FOV: 45 degrees, 2346x1568, retinal fundus photograph: 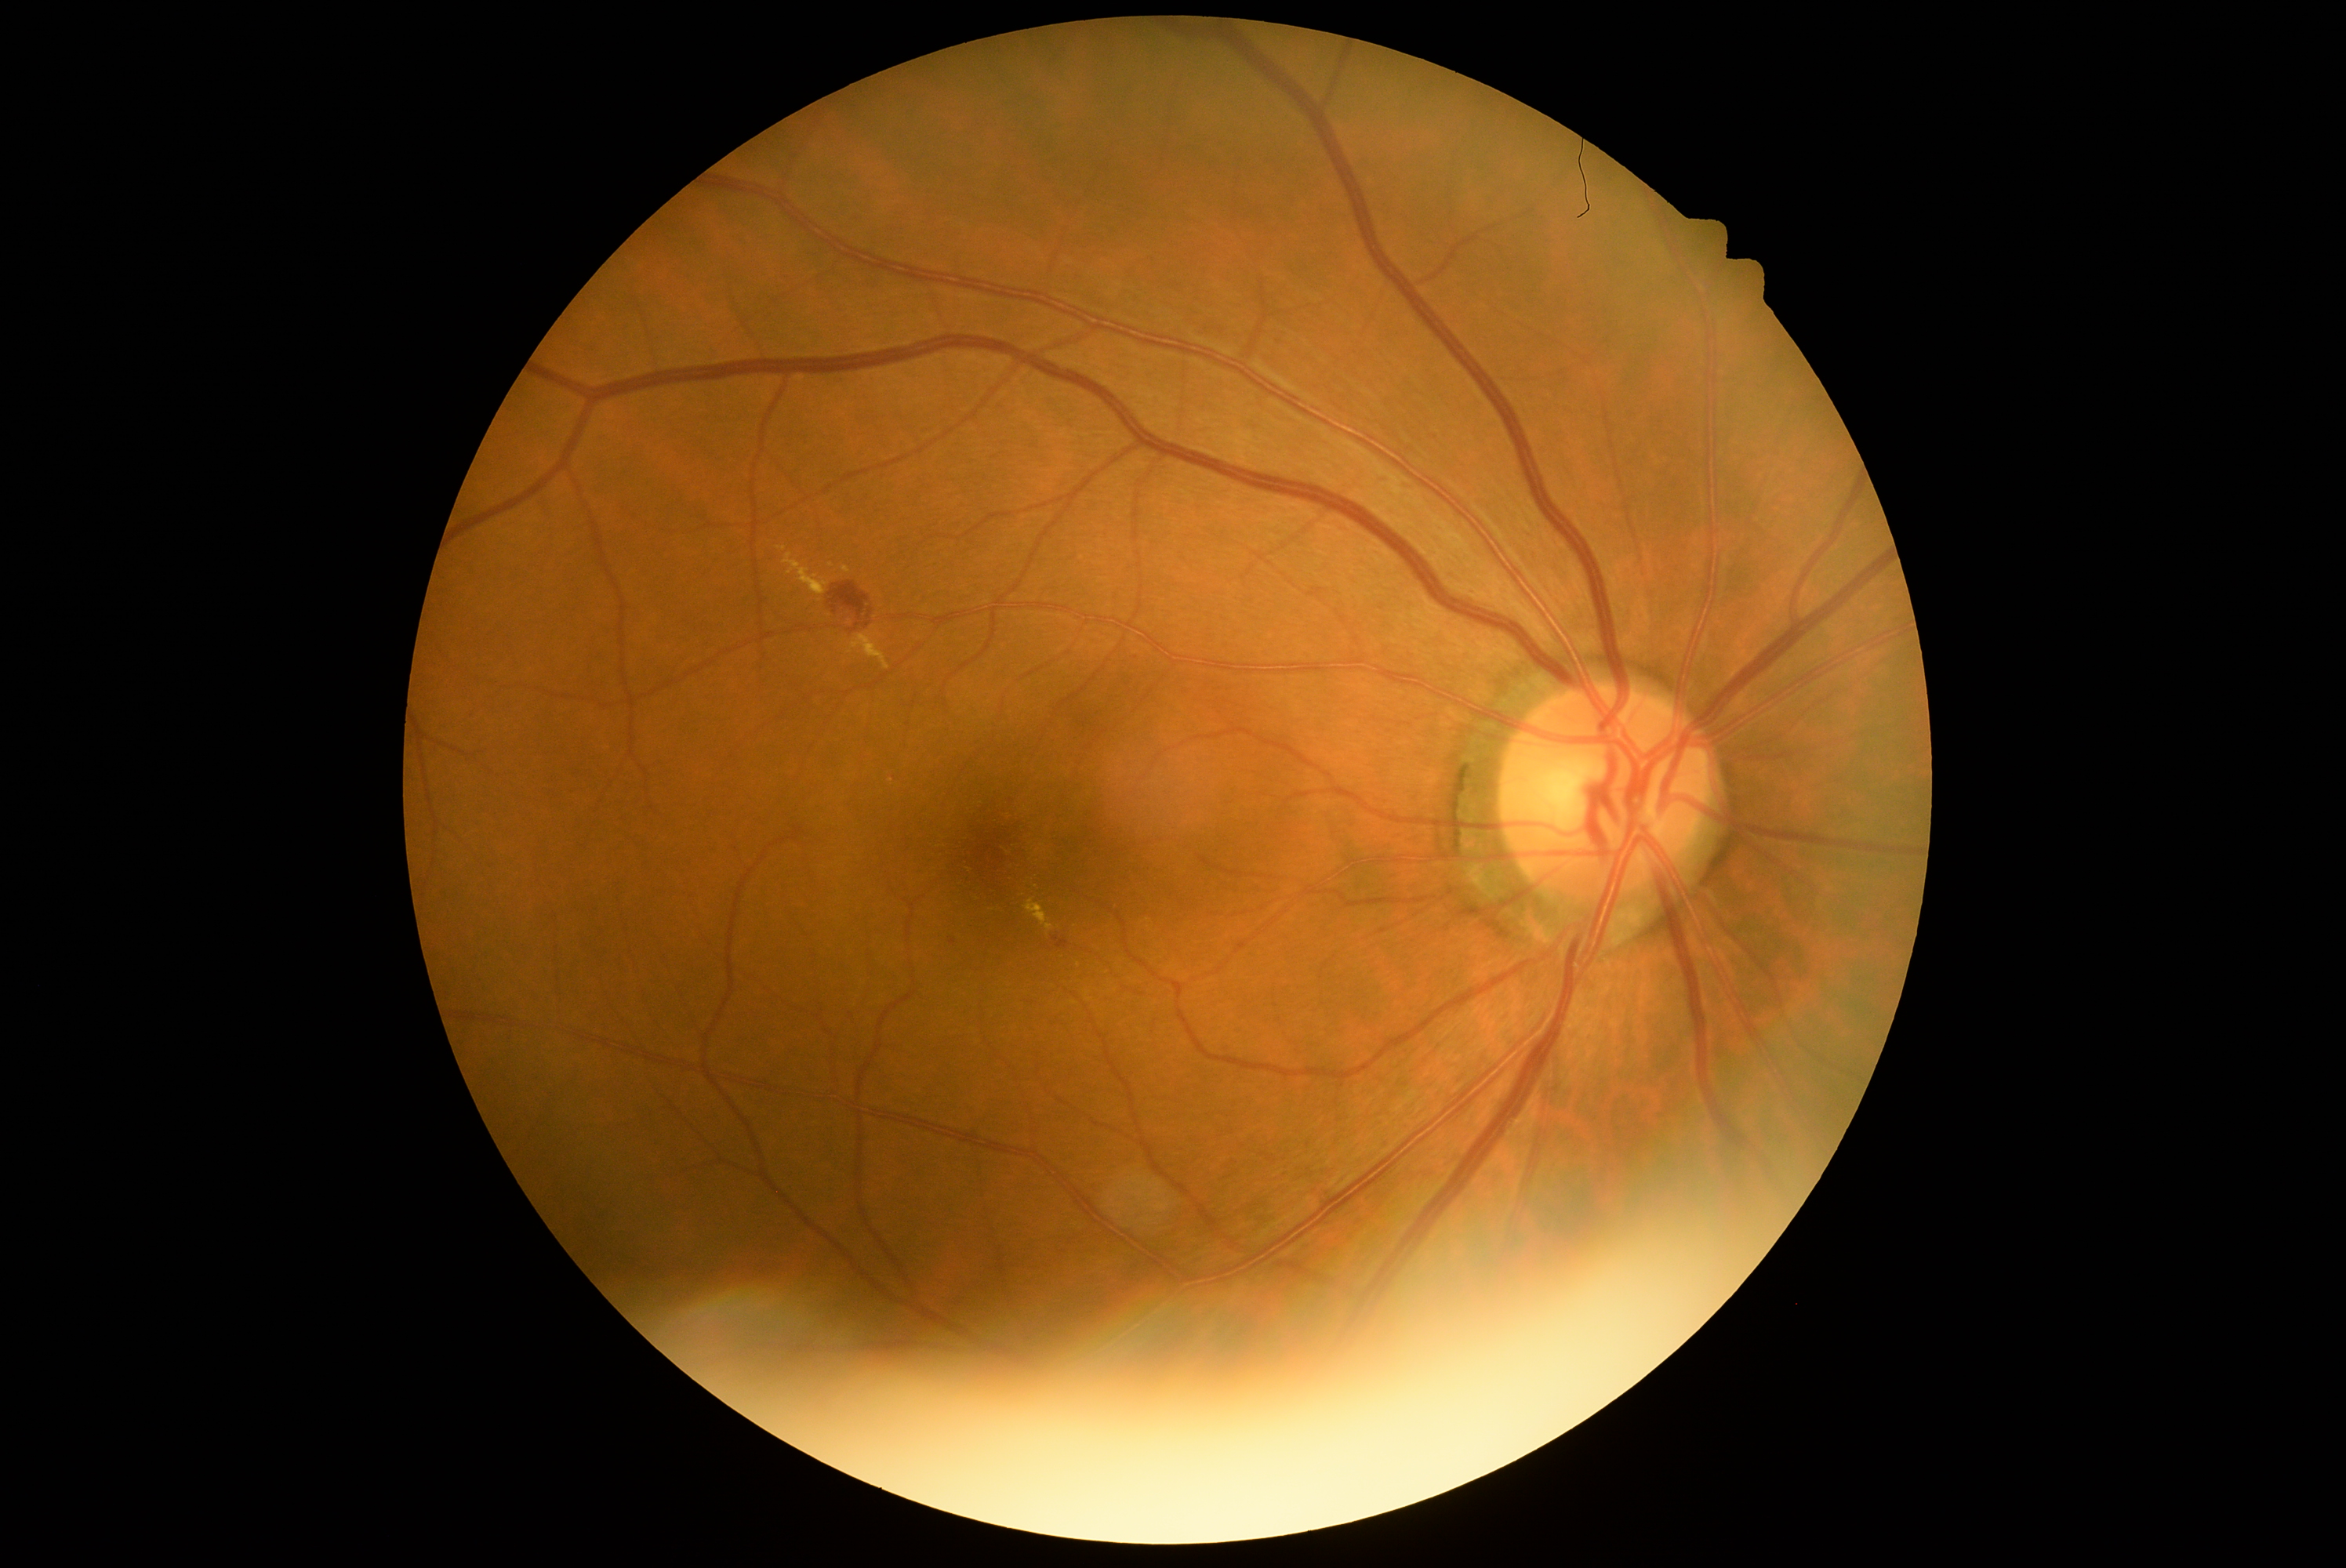

Diabetic retinopathy: grade 2 (moderate NPDR) — more than just microaneurysms but less than severe NPDR
soft exudates = not present
microaneurysms = not present
hard exudates = Rect(777, 546, 786, 551), Rect(783, 553, 830, 595), Rect(843, 565, 851, 573), Rect(849, 633, 892, 670), Rect(1026, 899, 1055, 931)
Small hard exudates approximately at <pt>831,565</pt>
hemorrhages = Rect(830, 583, 870, 631), Rect(866, 608, 873, 620), Rect(1053, 937, 1069, 948)
Small hemorrhages approximately at <pt>867,625</pt>, <pt>953,941</pt>